Camera: Topcon TRC-50DX.
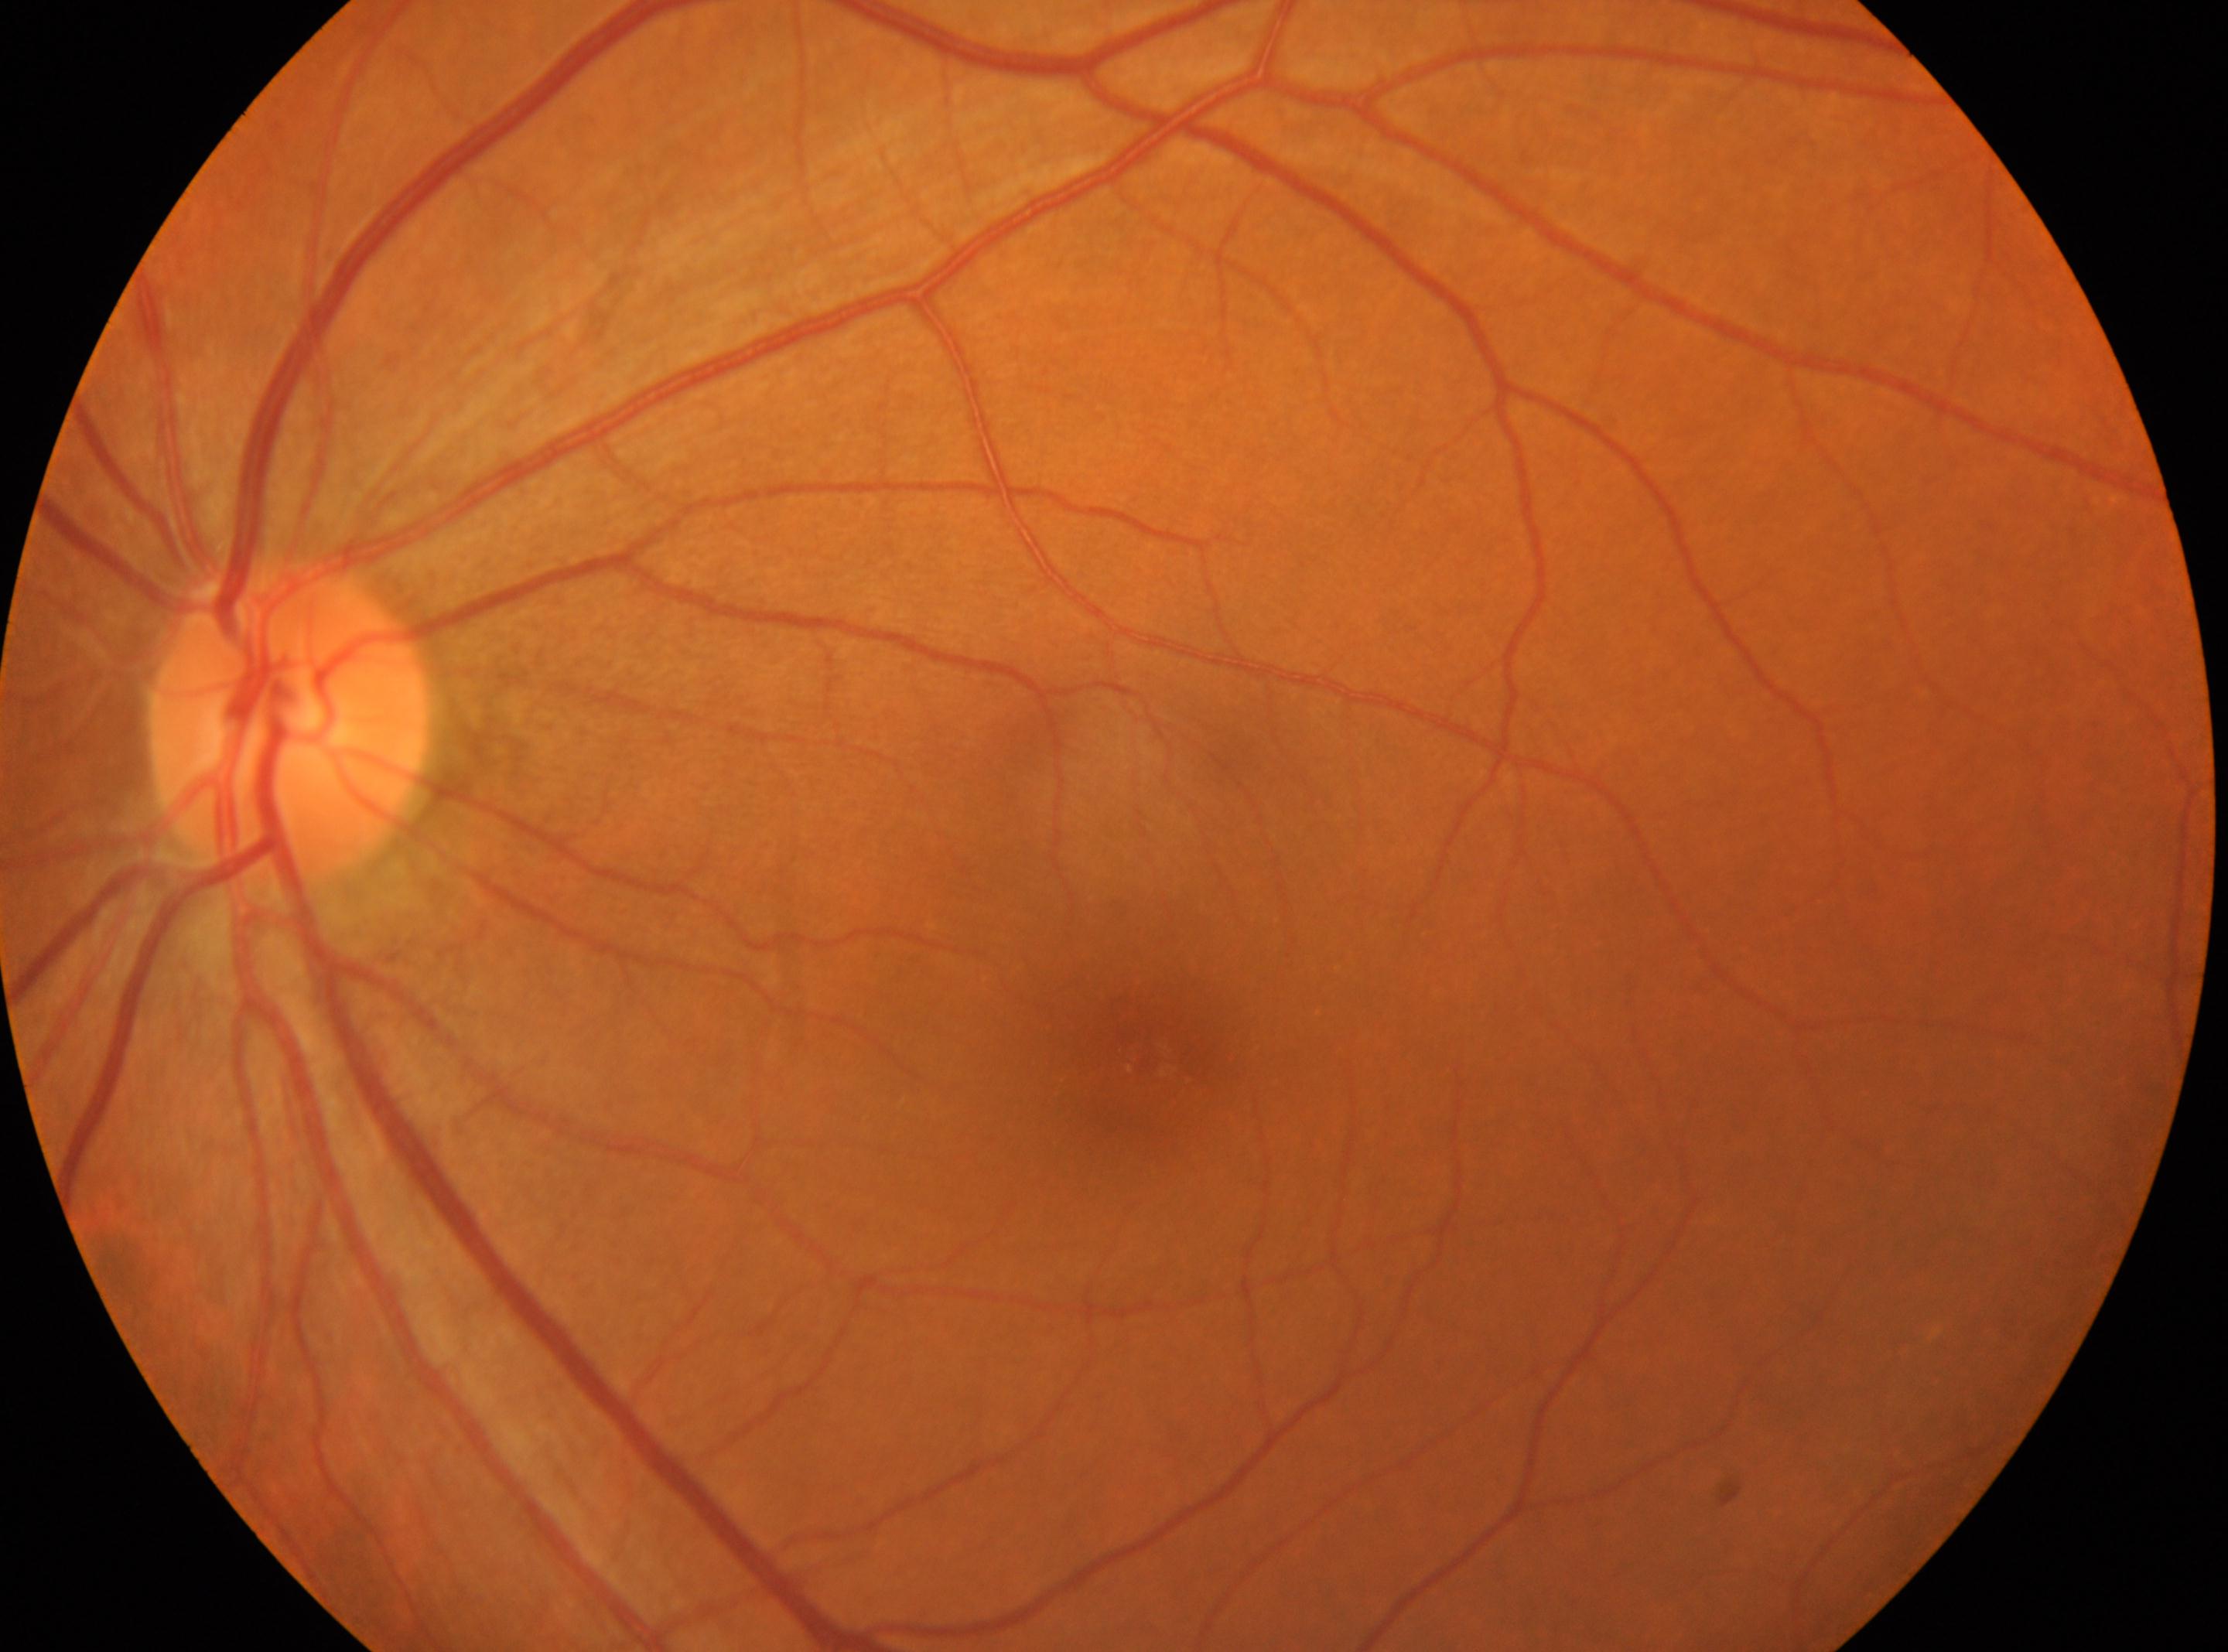
Annotations:
– optic disk · x=290, y=725
– macular center · x=1145, y=1058
– laterality · the left eye
– DR · 0 — no visible signs of diabetic retinopathy